Without pupil dilation: 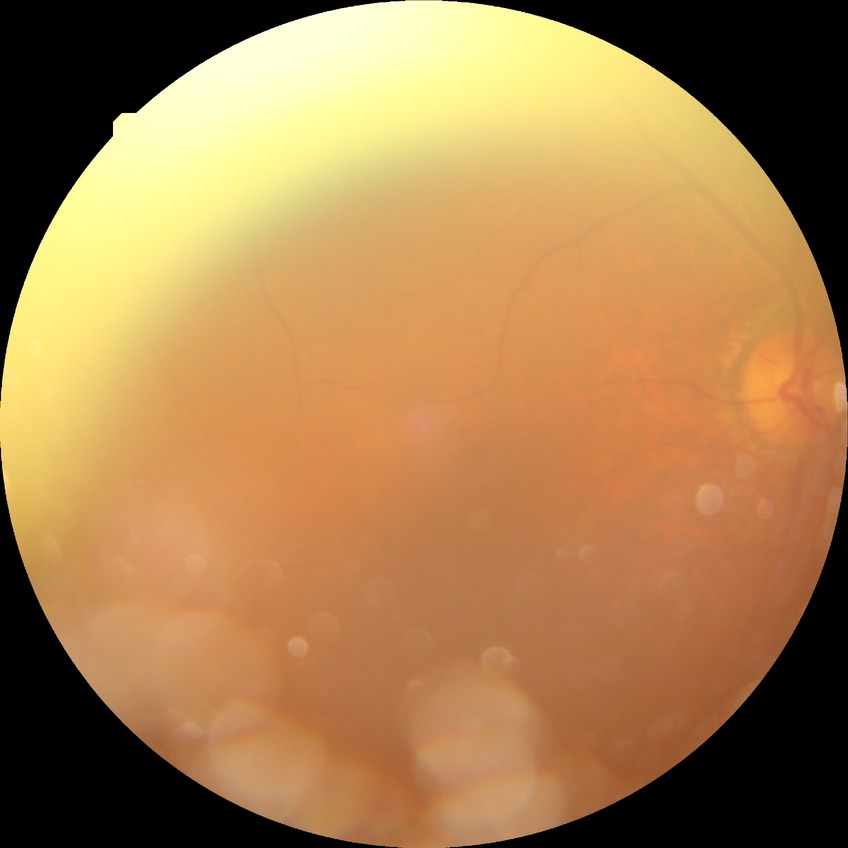   dr_impression: negative for DR
  davis_grade: NDR